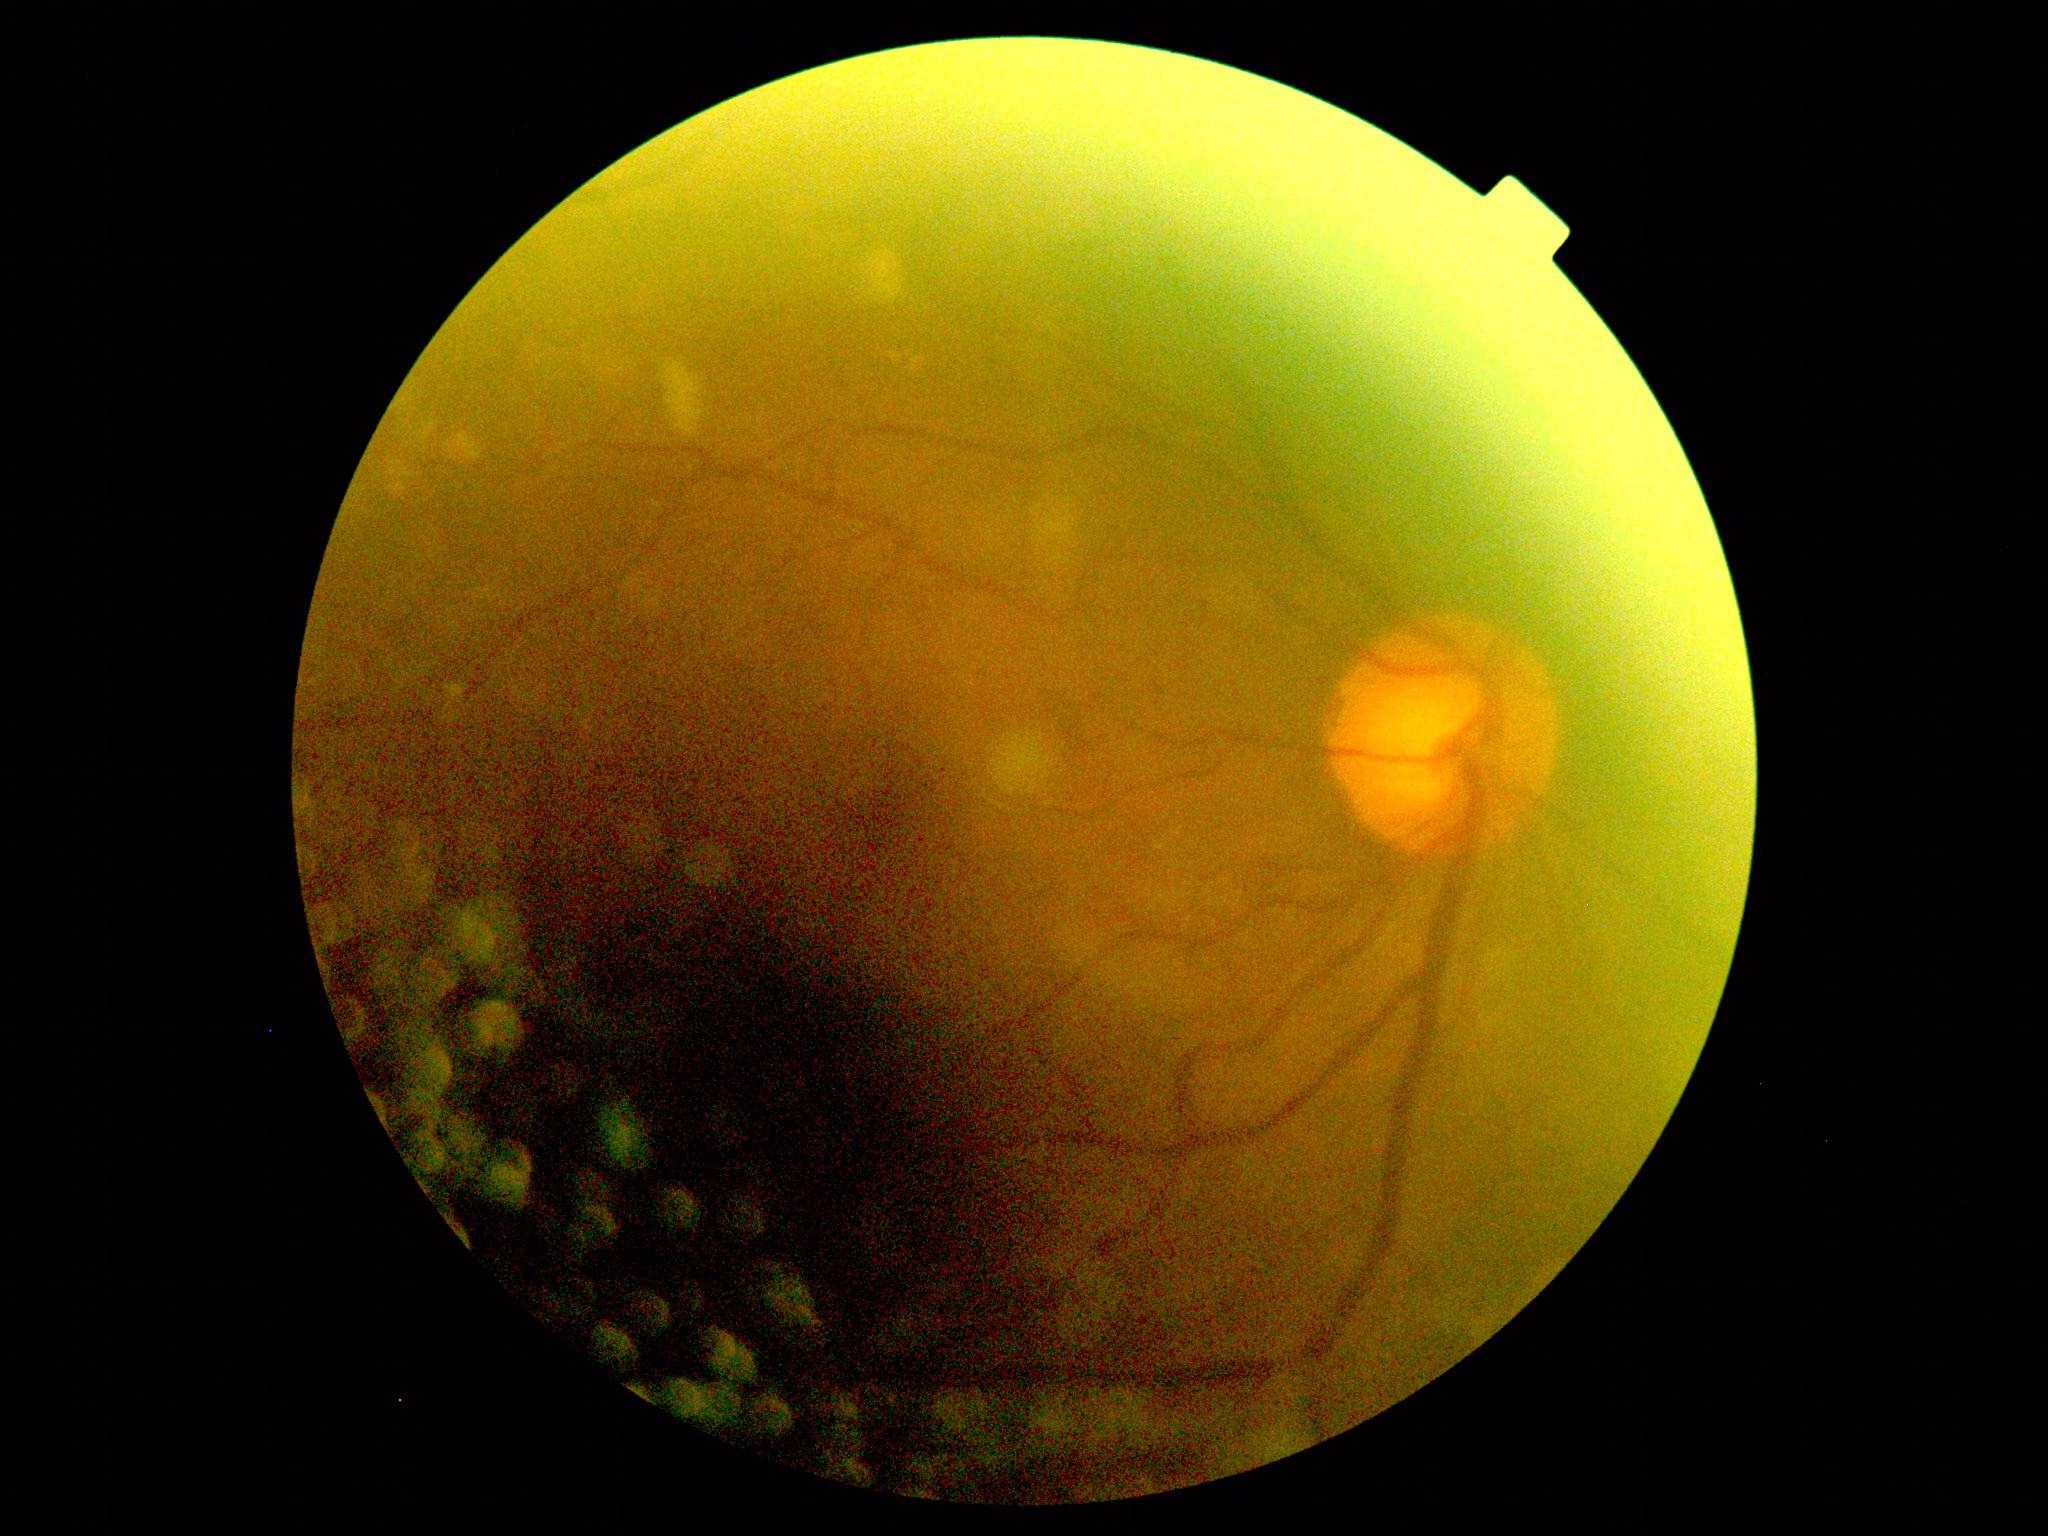 DR severity: grade 2 (moderate NPDR).